Diabetic retinopathy graded by the modified Davis classification: 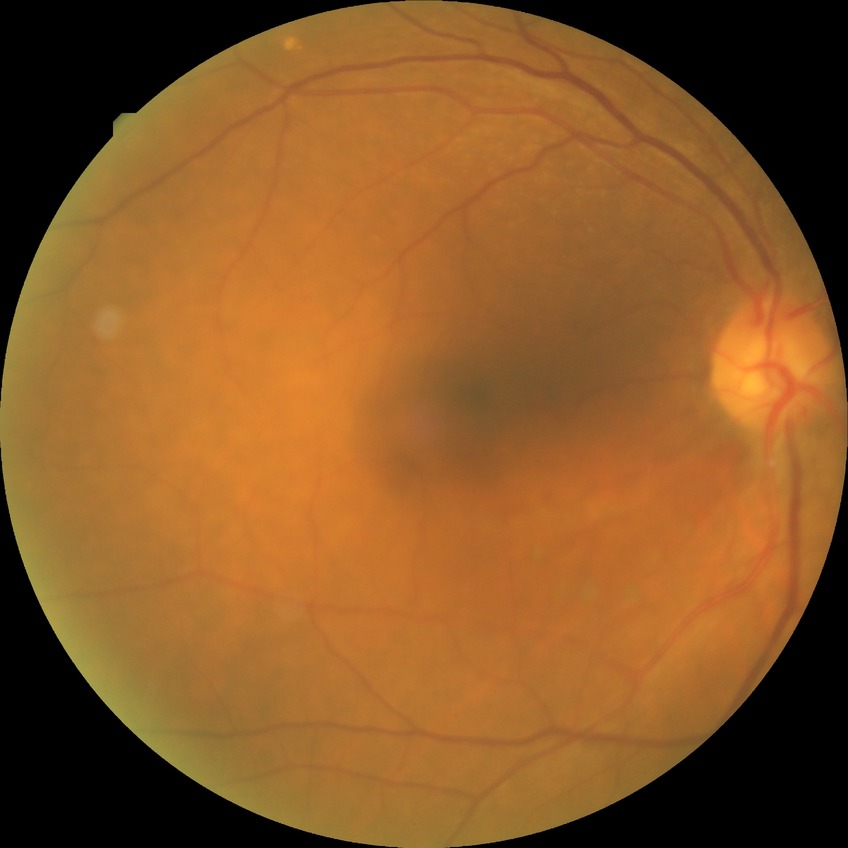

Diabetic retinopathy stage: no diabetic retinopathy.